Wide-field fundus photograph from neonatal ROP screening.
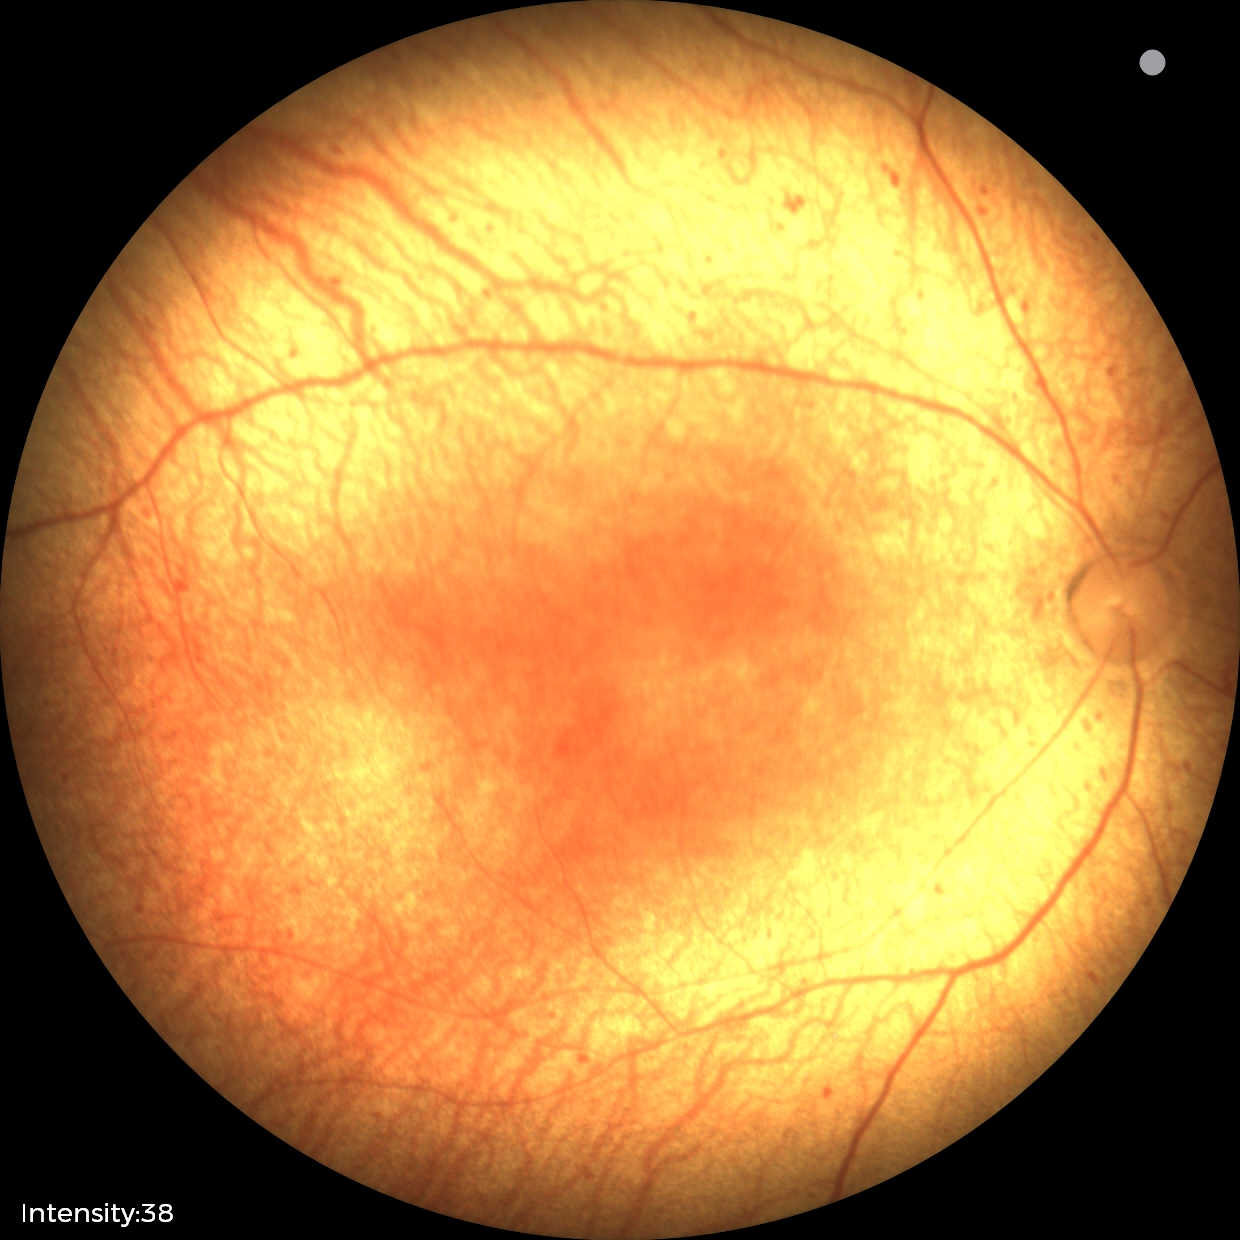
Diagnosis from this screening exam: status post ROP — retinal appearance after treated retinopathy of prematurity.